CFP, 45° field of view: 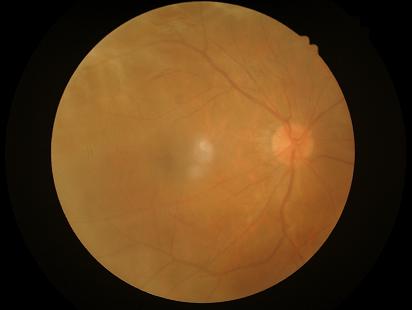 Vessels and details are hard to distinguish. Out of focus; structures are indistinct. No over- or under-exposure. Image quality is inadequate for diagnostic use.